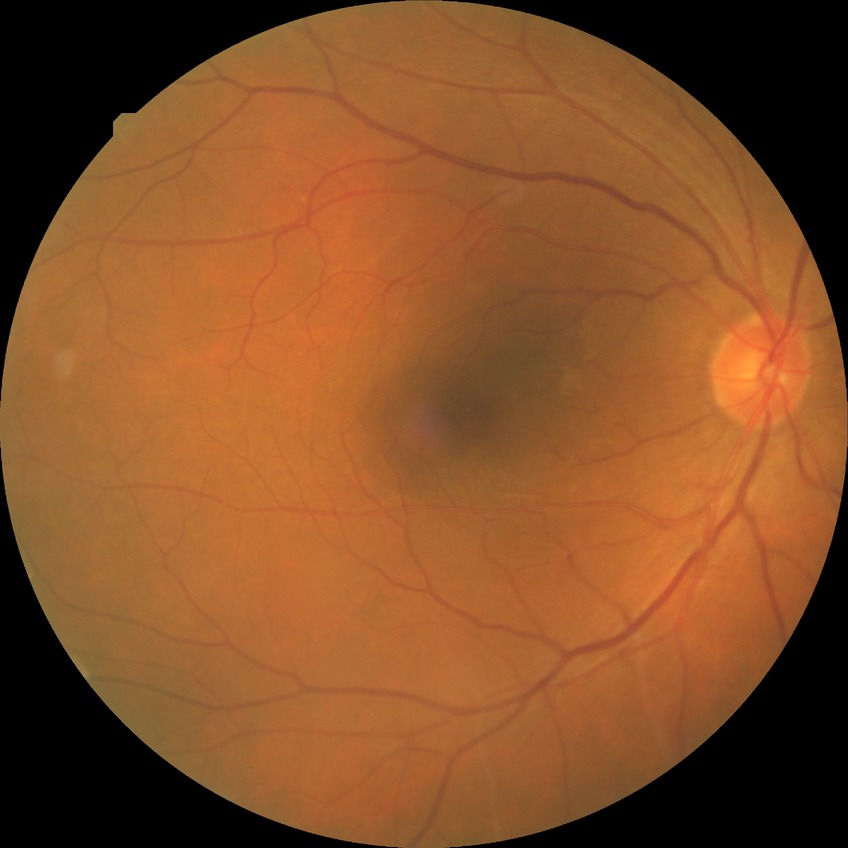
Diabetic retinopathy grade is no diabetic retinopathy.